2352x1568px.
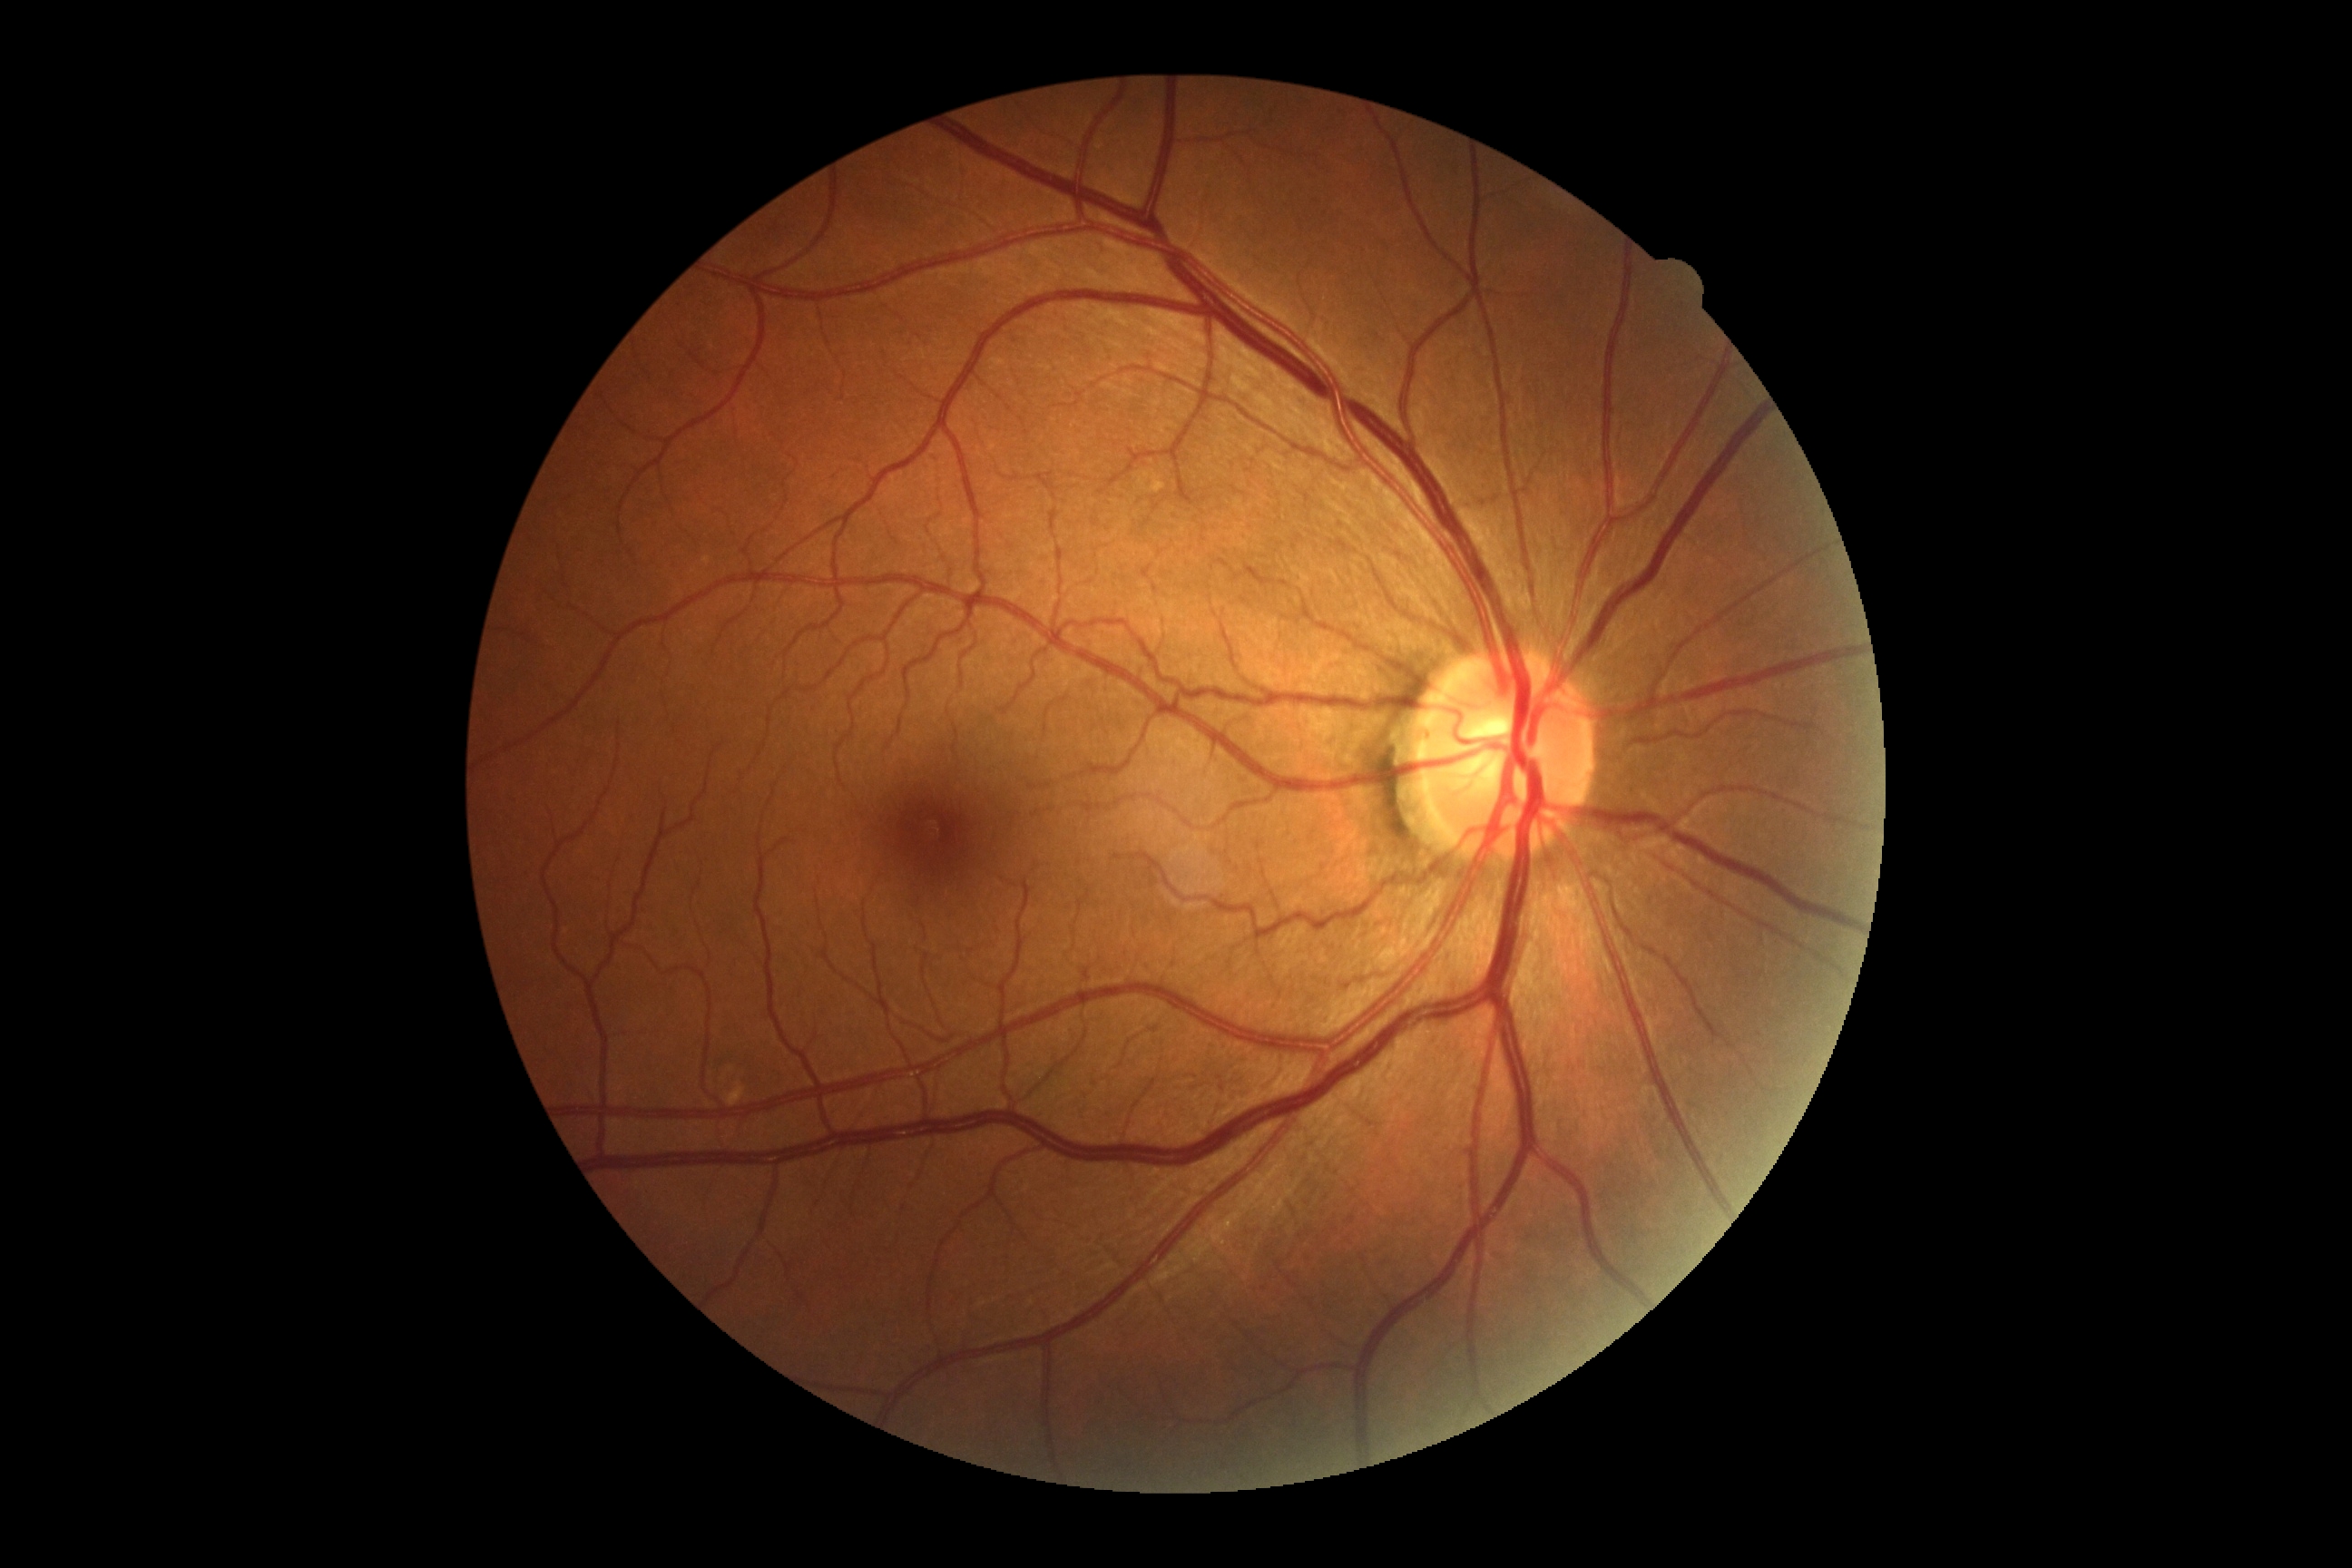
diabetic retinopathy (DR): grade 0 (no apparent retinopathy).